CFP:
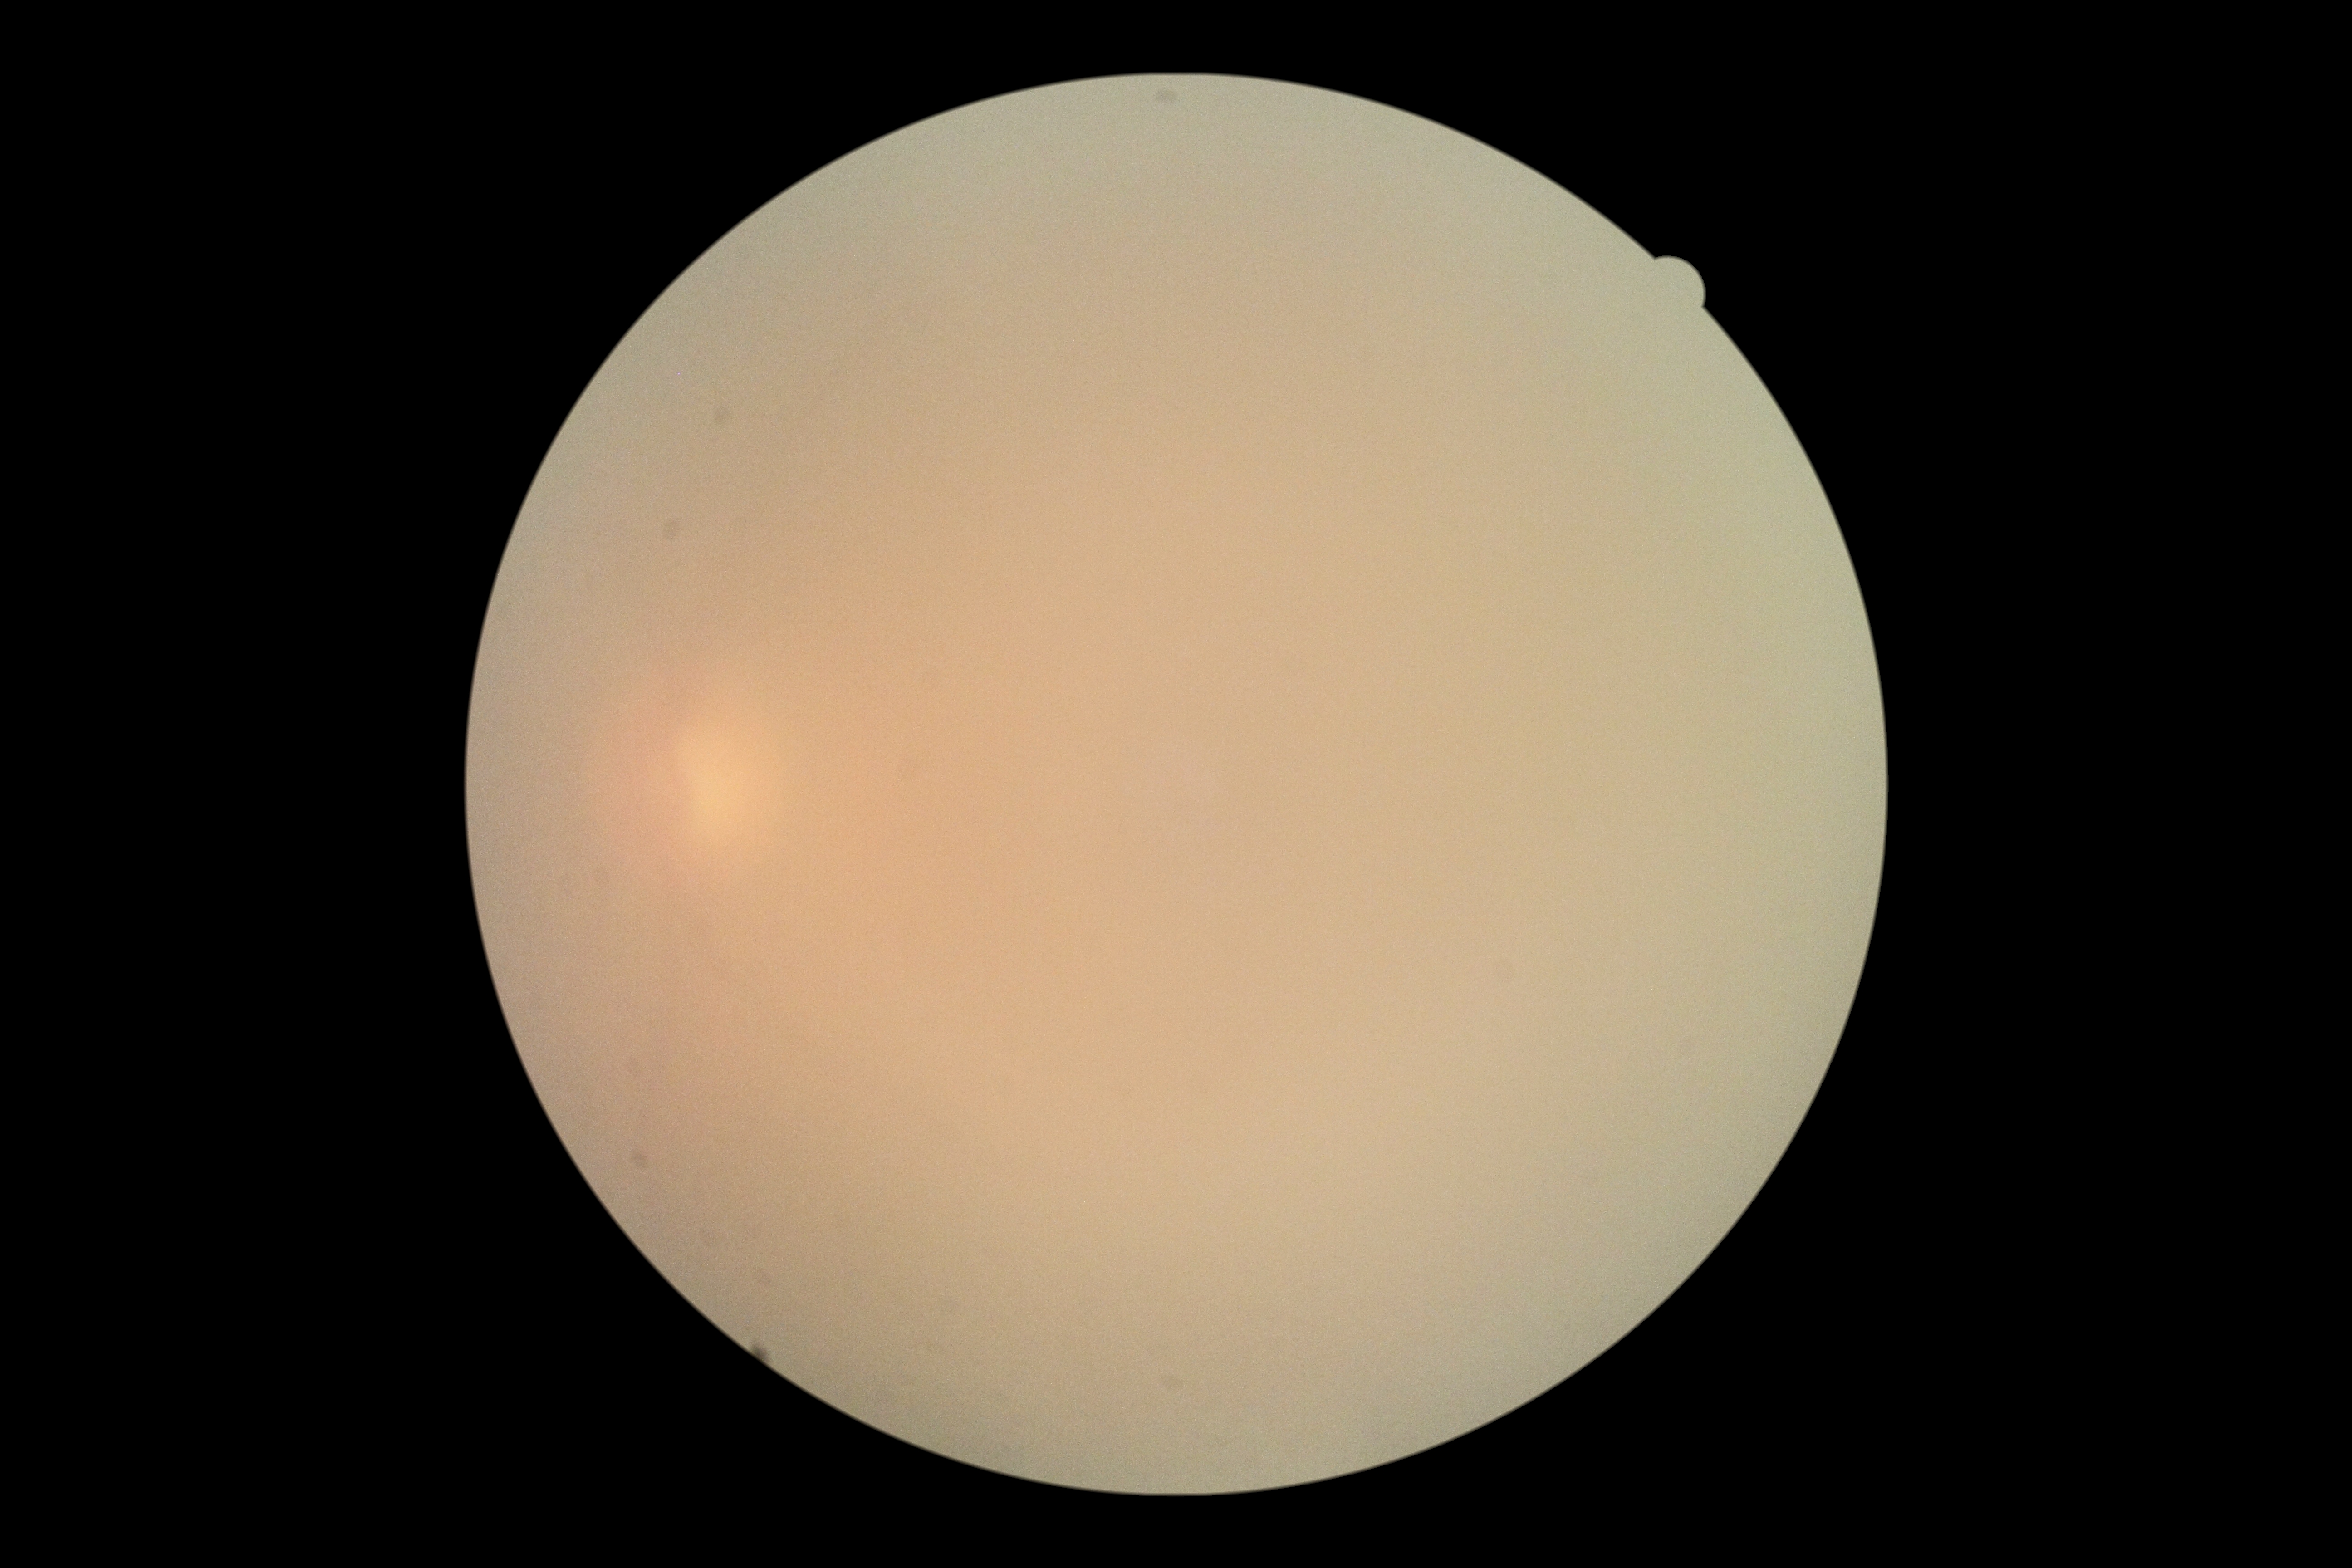 Diabetic retinopathy severity: ungradable due to poor image quality. Image quality is insufficient for diabetic retinopathy assessment.